FOV: 45 degrees
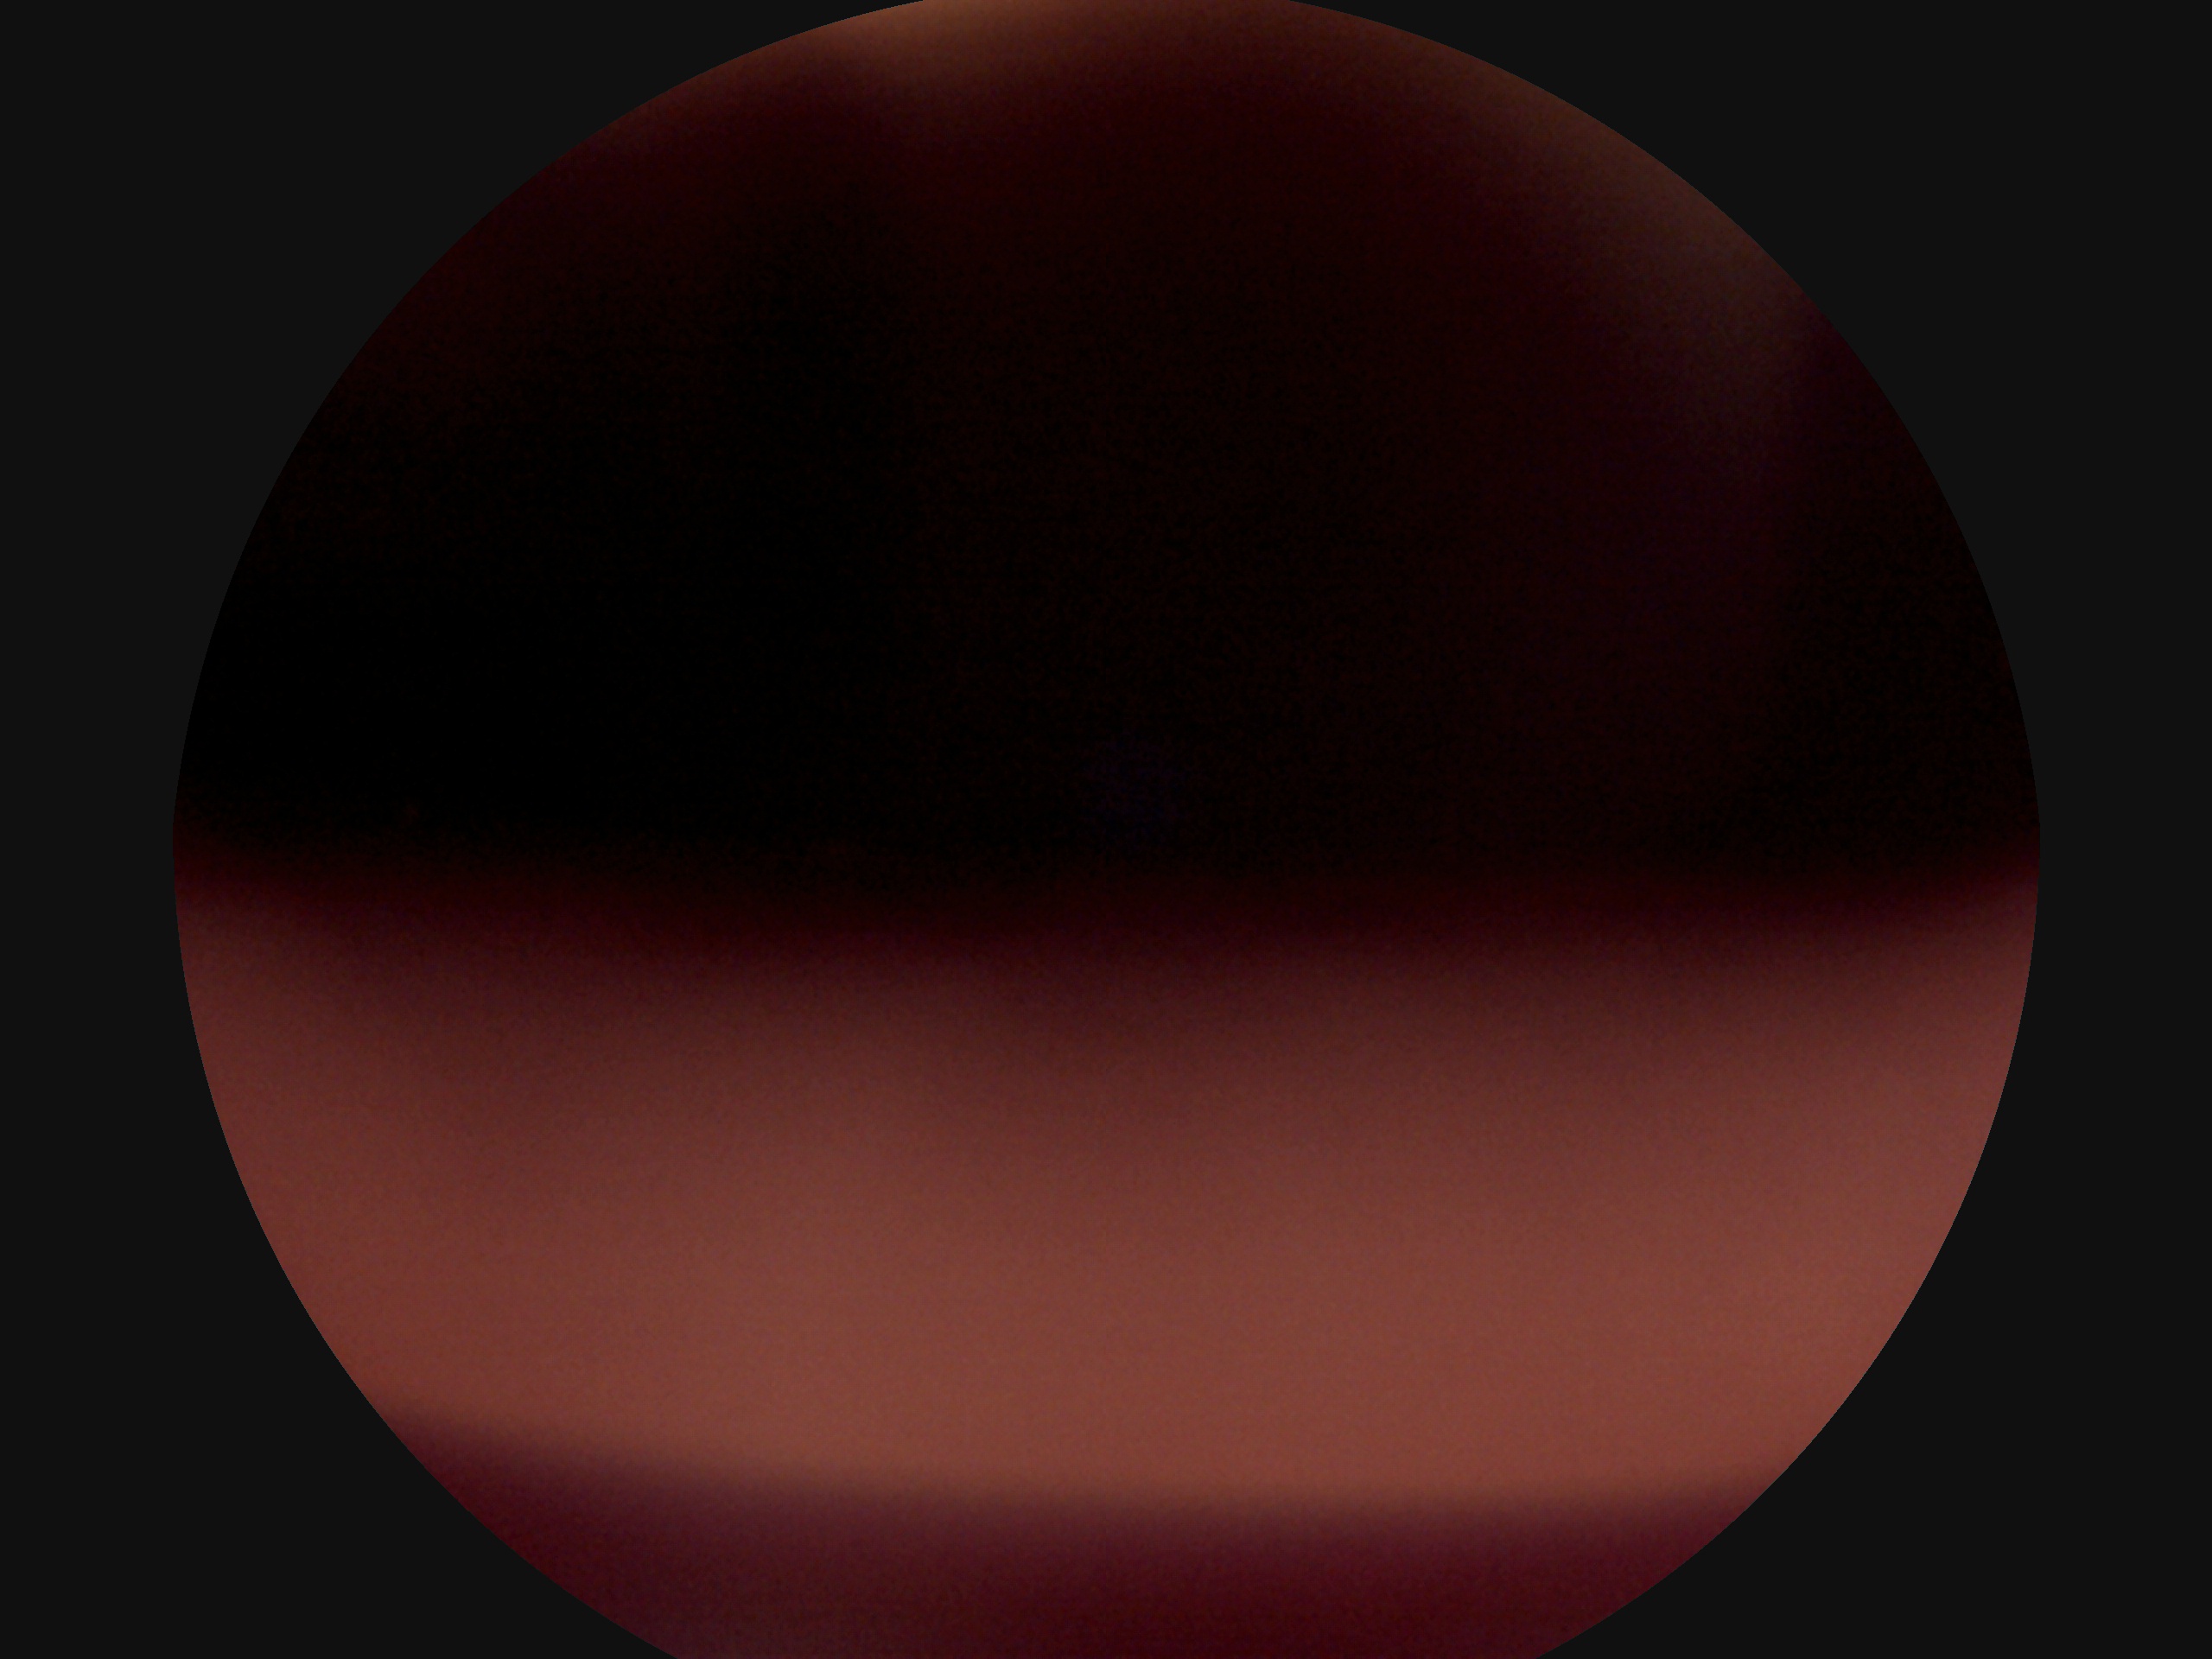 Diabetic retinopathy (DR): ungradable due to poor image quality.